CFP.
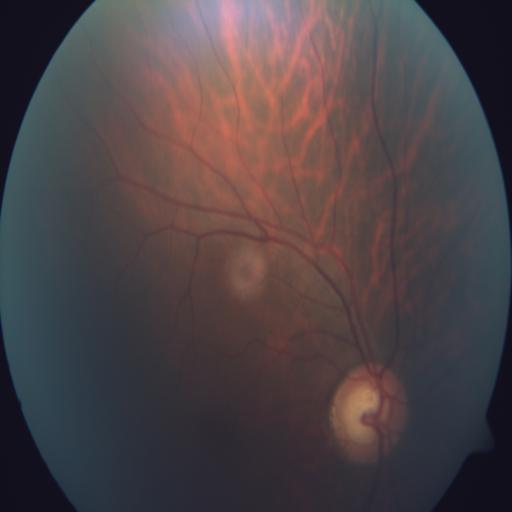 Abnormalities: optic disc cupping; tessellation.